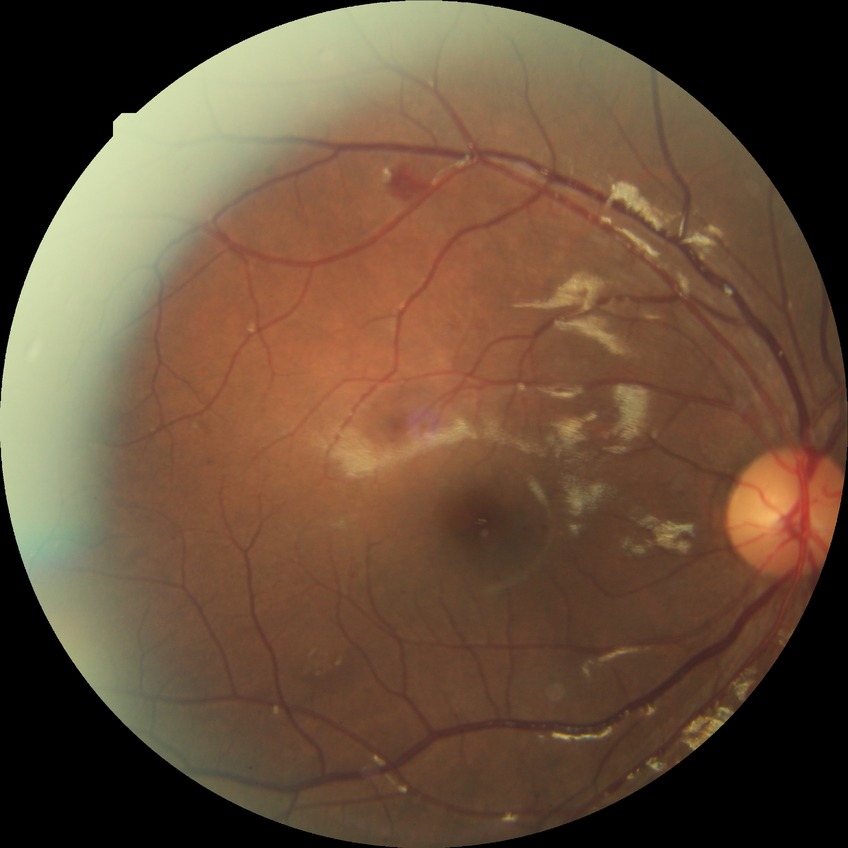

Disease class: non-proliferative diabetic retinopathy.
Diabetic retinopathy (DR): simple diabetic retinopathy (SDR).